Wide-field fundus photograph from neonatal ROP screening; 1240x1240px; camera: Phoenix ICON (100° FOV):
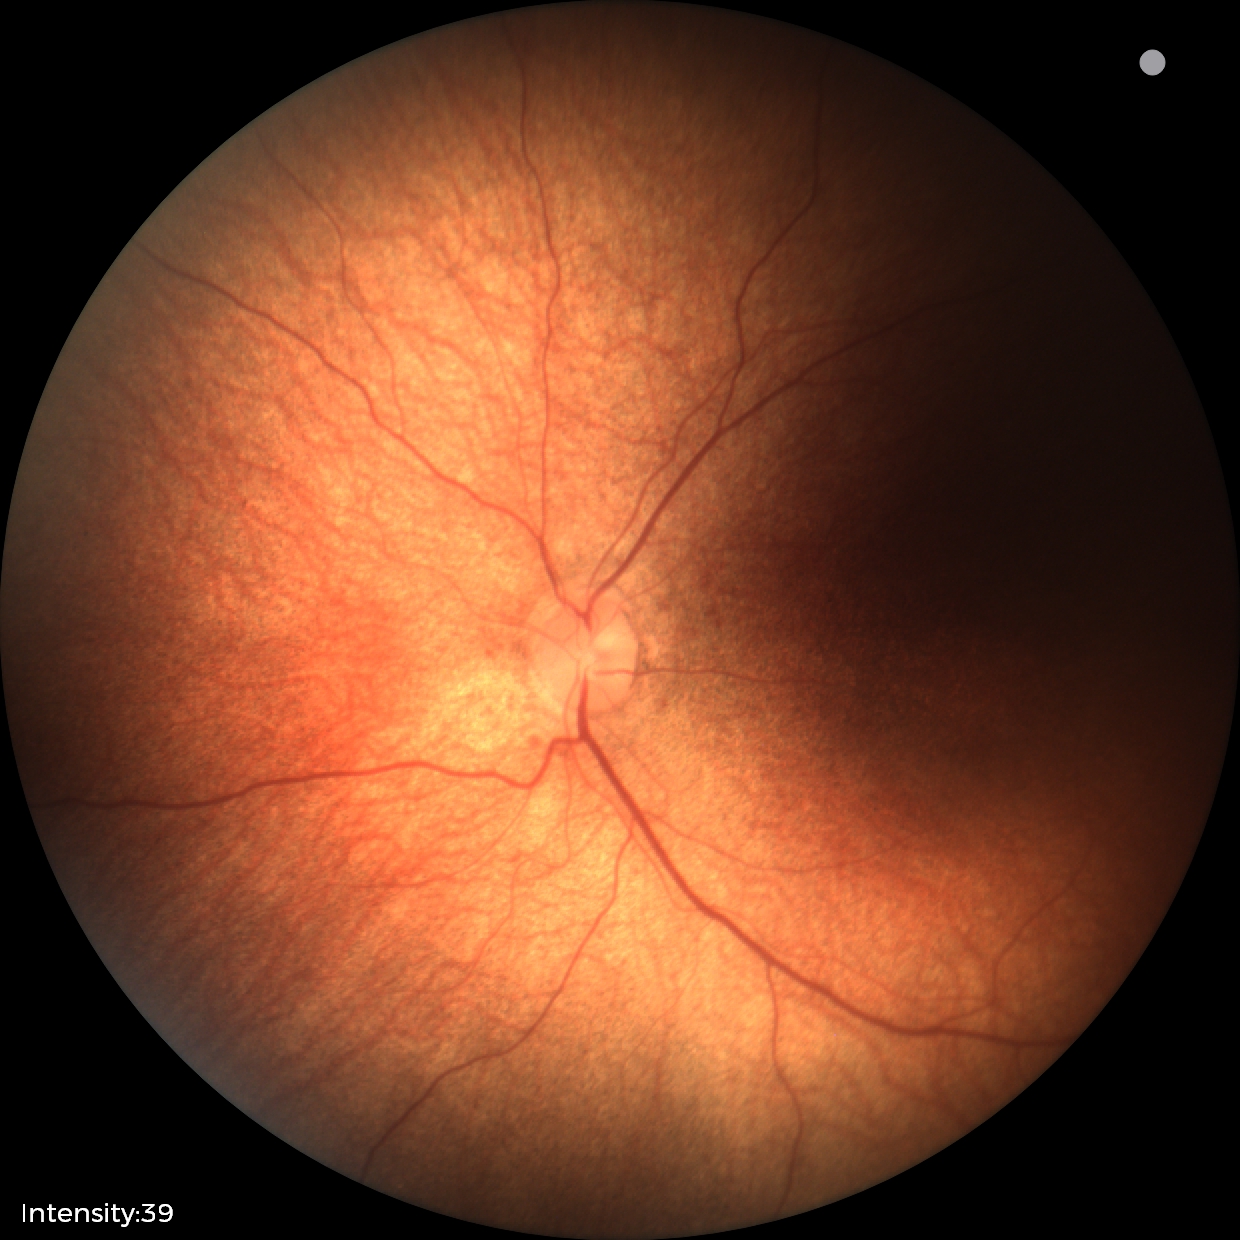
Screening examination with no abnormal retinal findings.